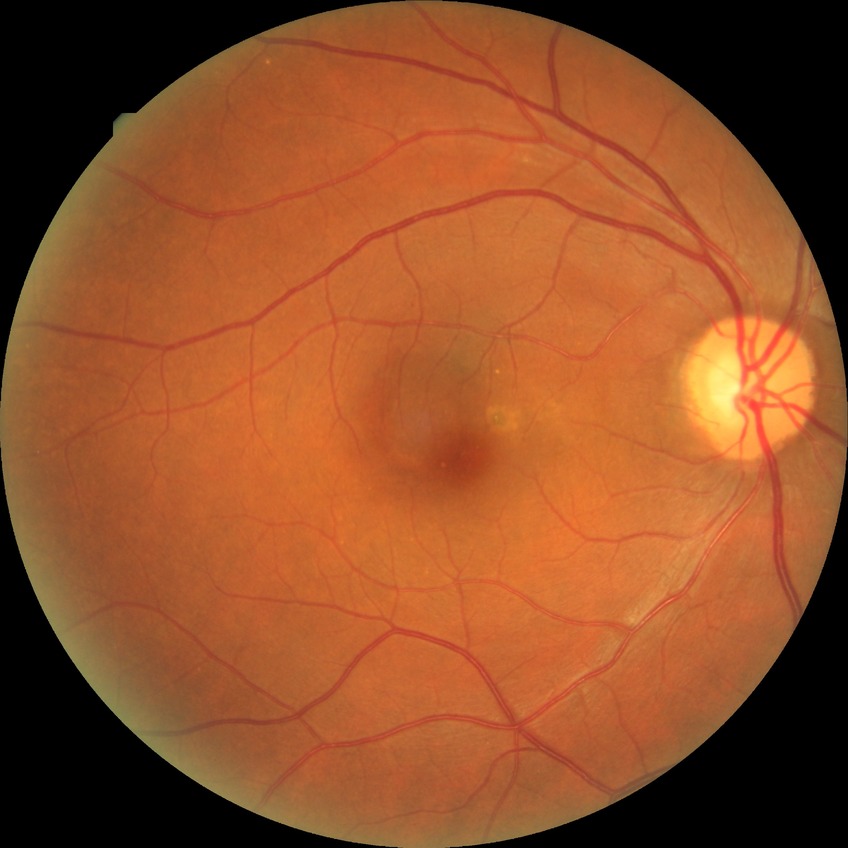

Diabetic retinopathy (DR): NDR (no diabetic retinopathy).